Acquired with a NIDEK AFC-230: 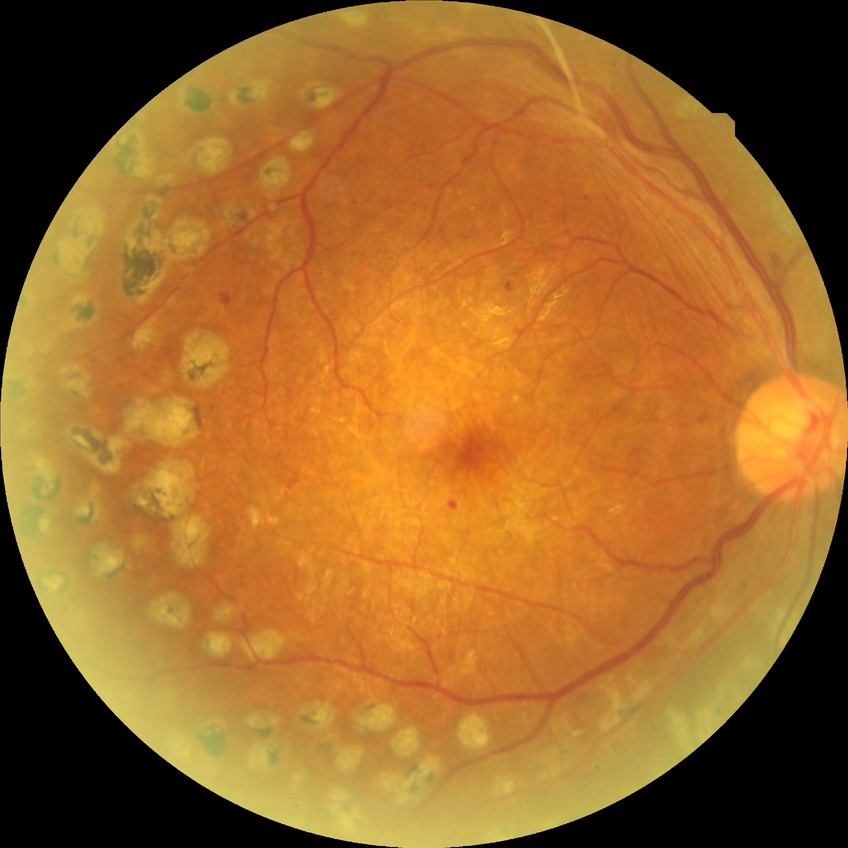
DR grade: PDR.